Tabletop color fundus camera image, 45° FOV: 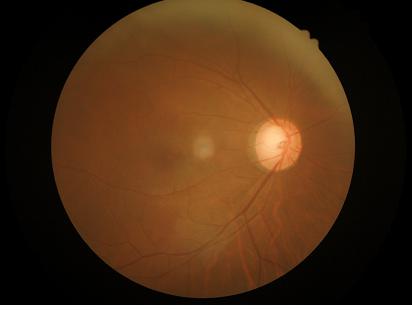
  illumination: over- or under-exposed
  overall_quality: inadequate for clinical interpretation
  contrast: low, vessels and details hard to distinguish